Modified Davis grading:
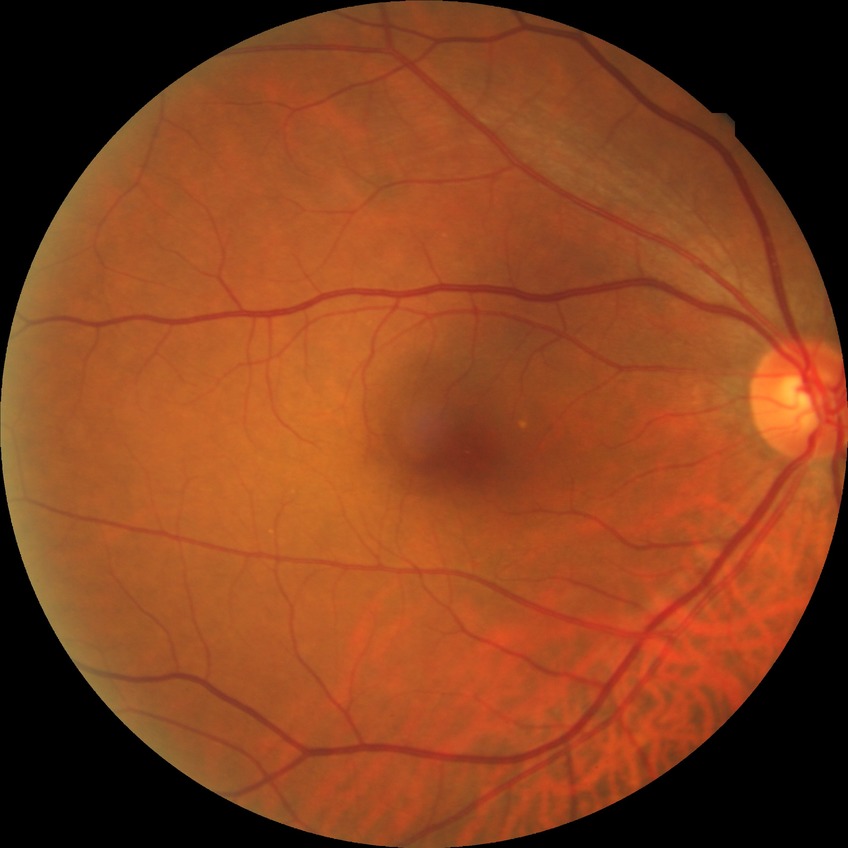 diabetic retinopathy (DR)@NDR (no diabetic retinopathy).